Fundus photo · 45° FOV · acquired with a NIDEK AFC-230:
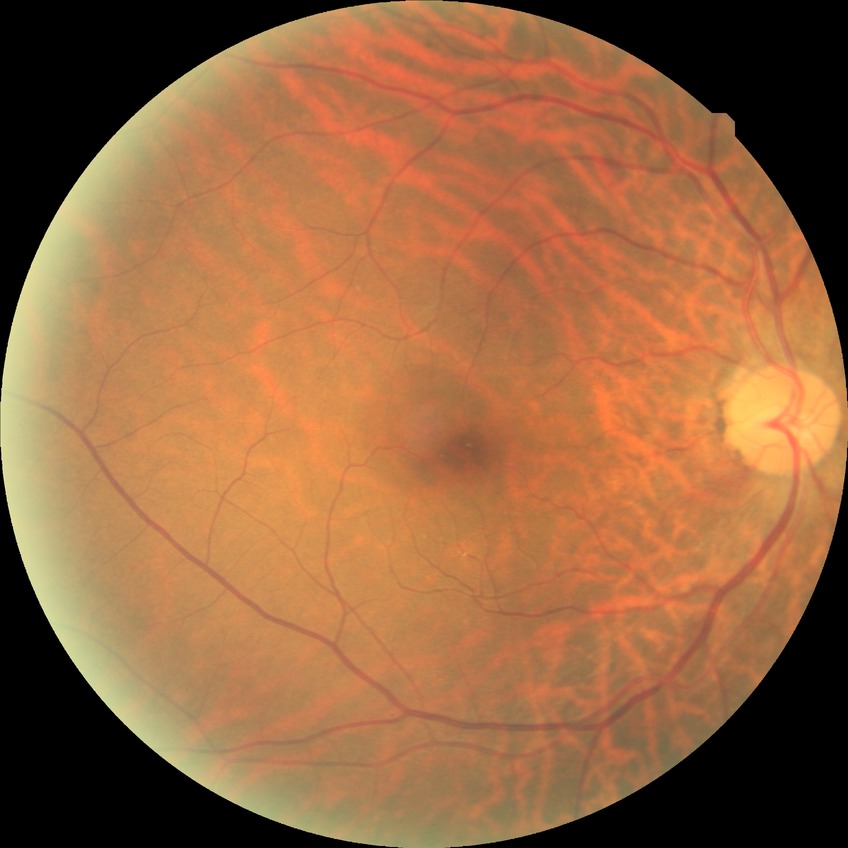

Diabetic retinopathy (DR) is NDR (no diabetic retinopathy).